240 by 240 pixels · camera: Nidek AFC-330 · centered on the optic disc
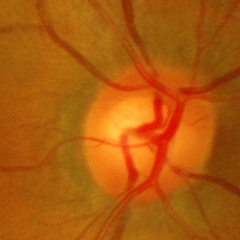 Glaucoma status: early glaucomatous optic neuropathy.